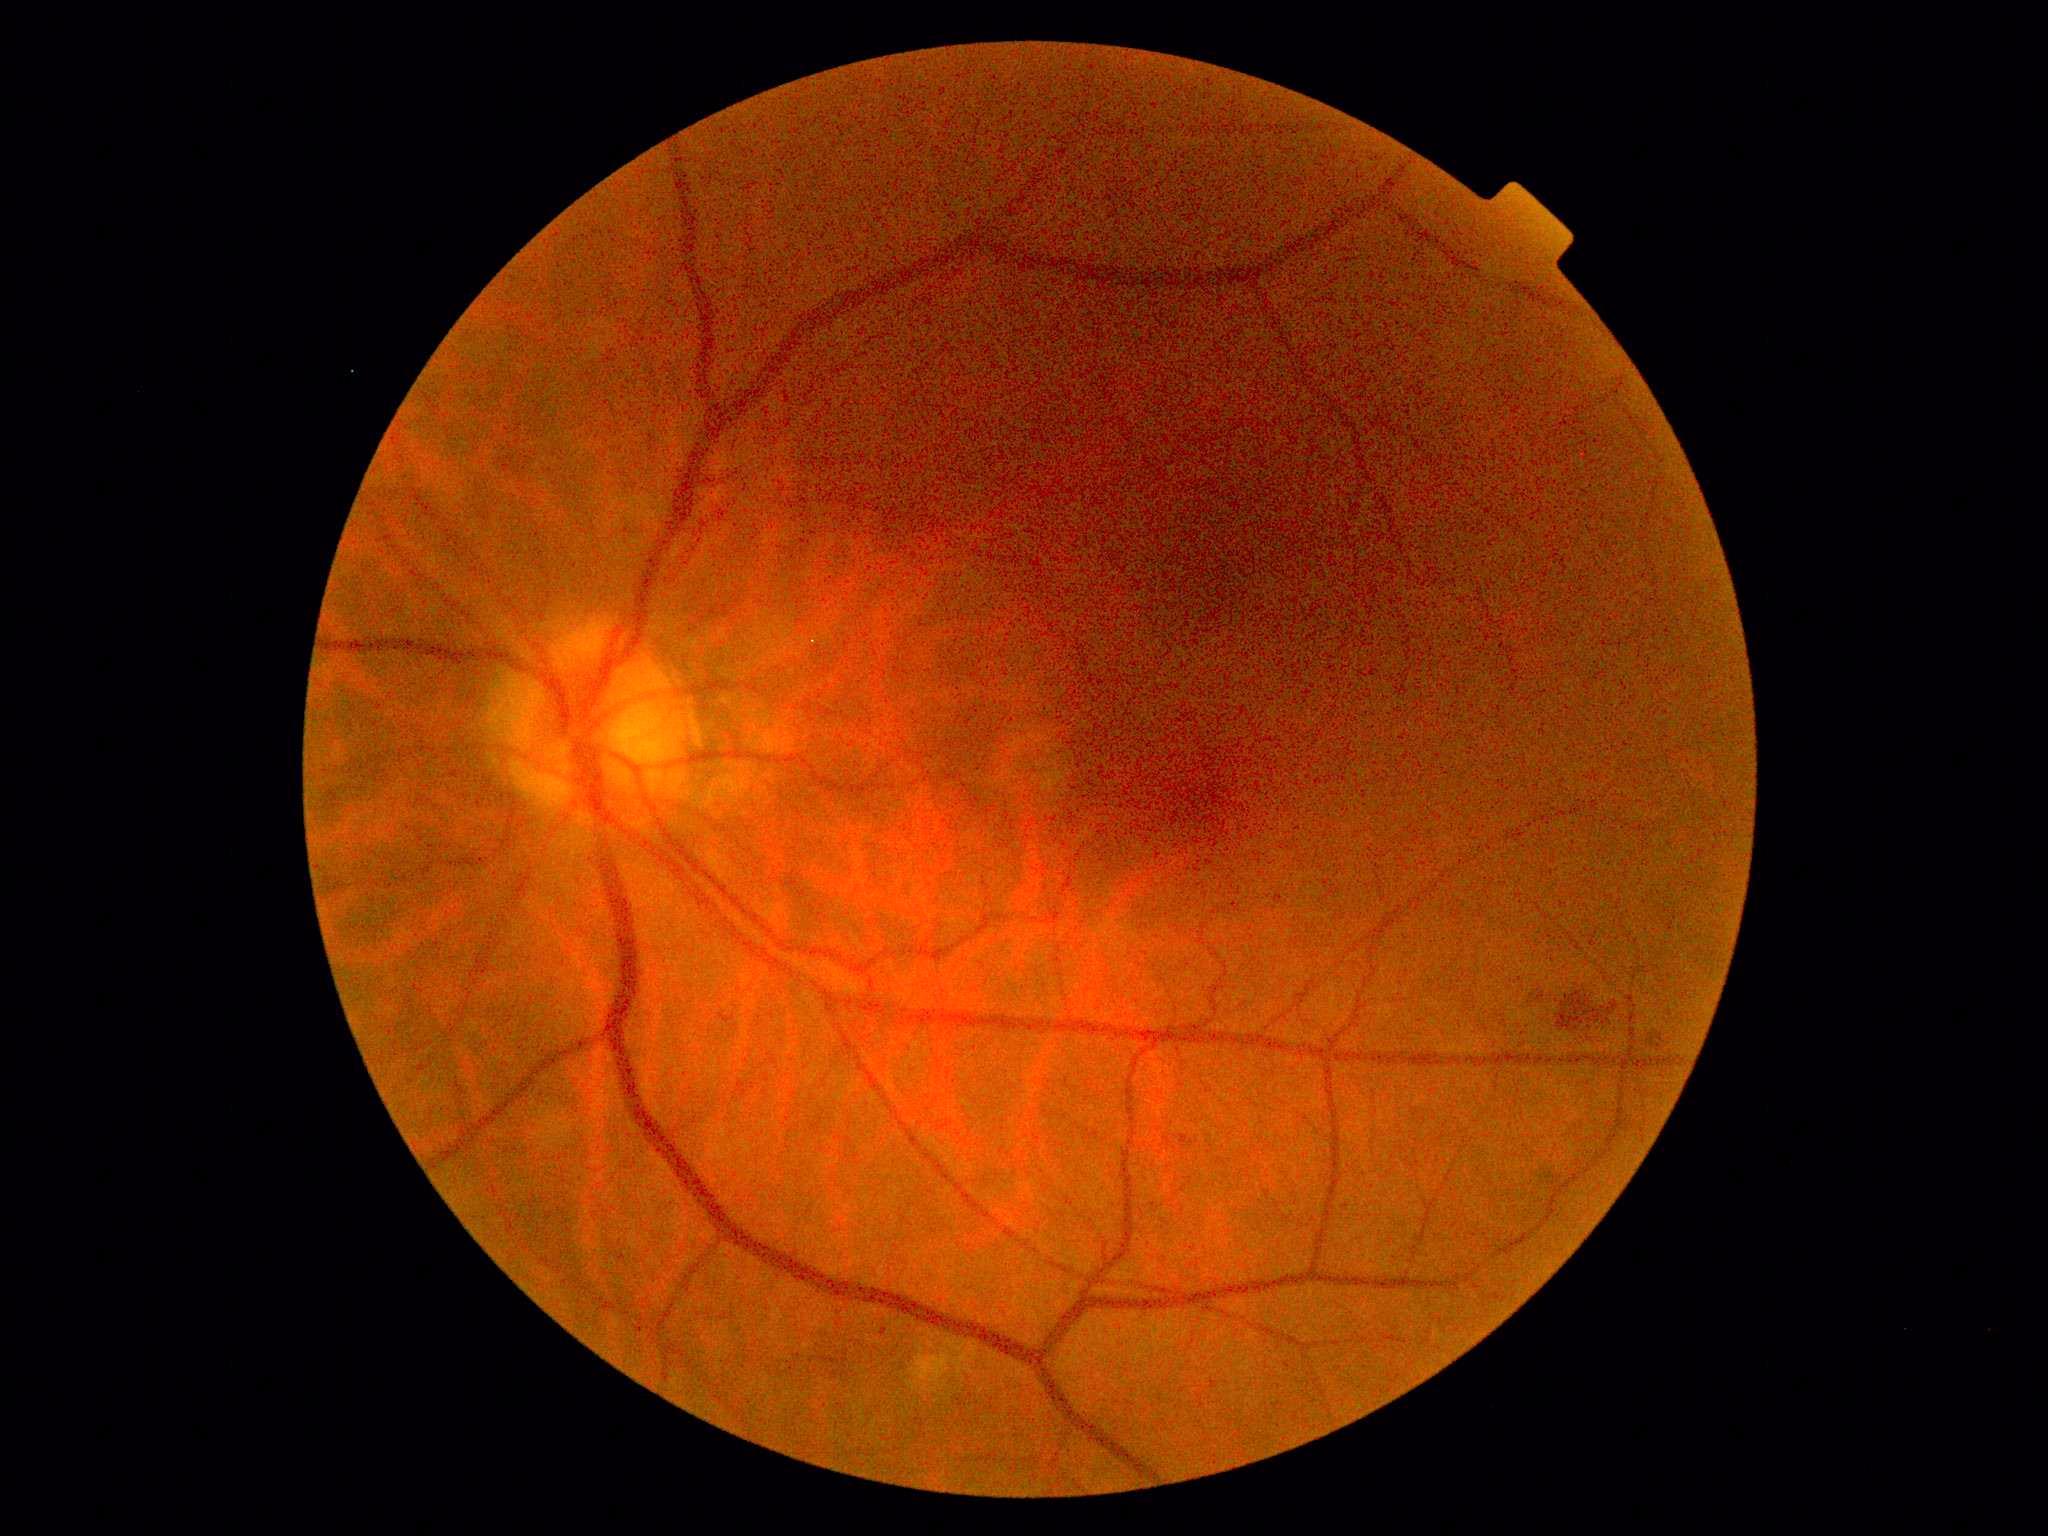
DR grade: 2 (moderate NPDR) — more than just microaneurysms but less than severe NPDR.
DR class: non-proliferative diabetic retinopathy.